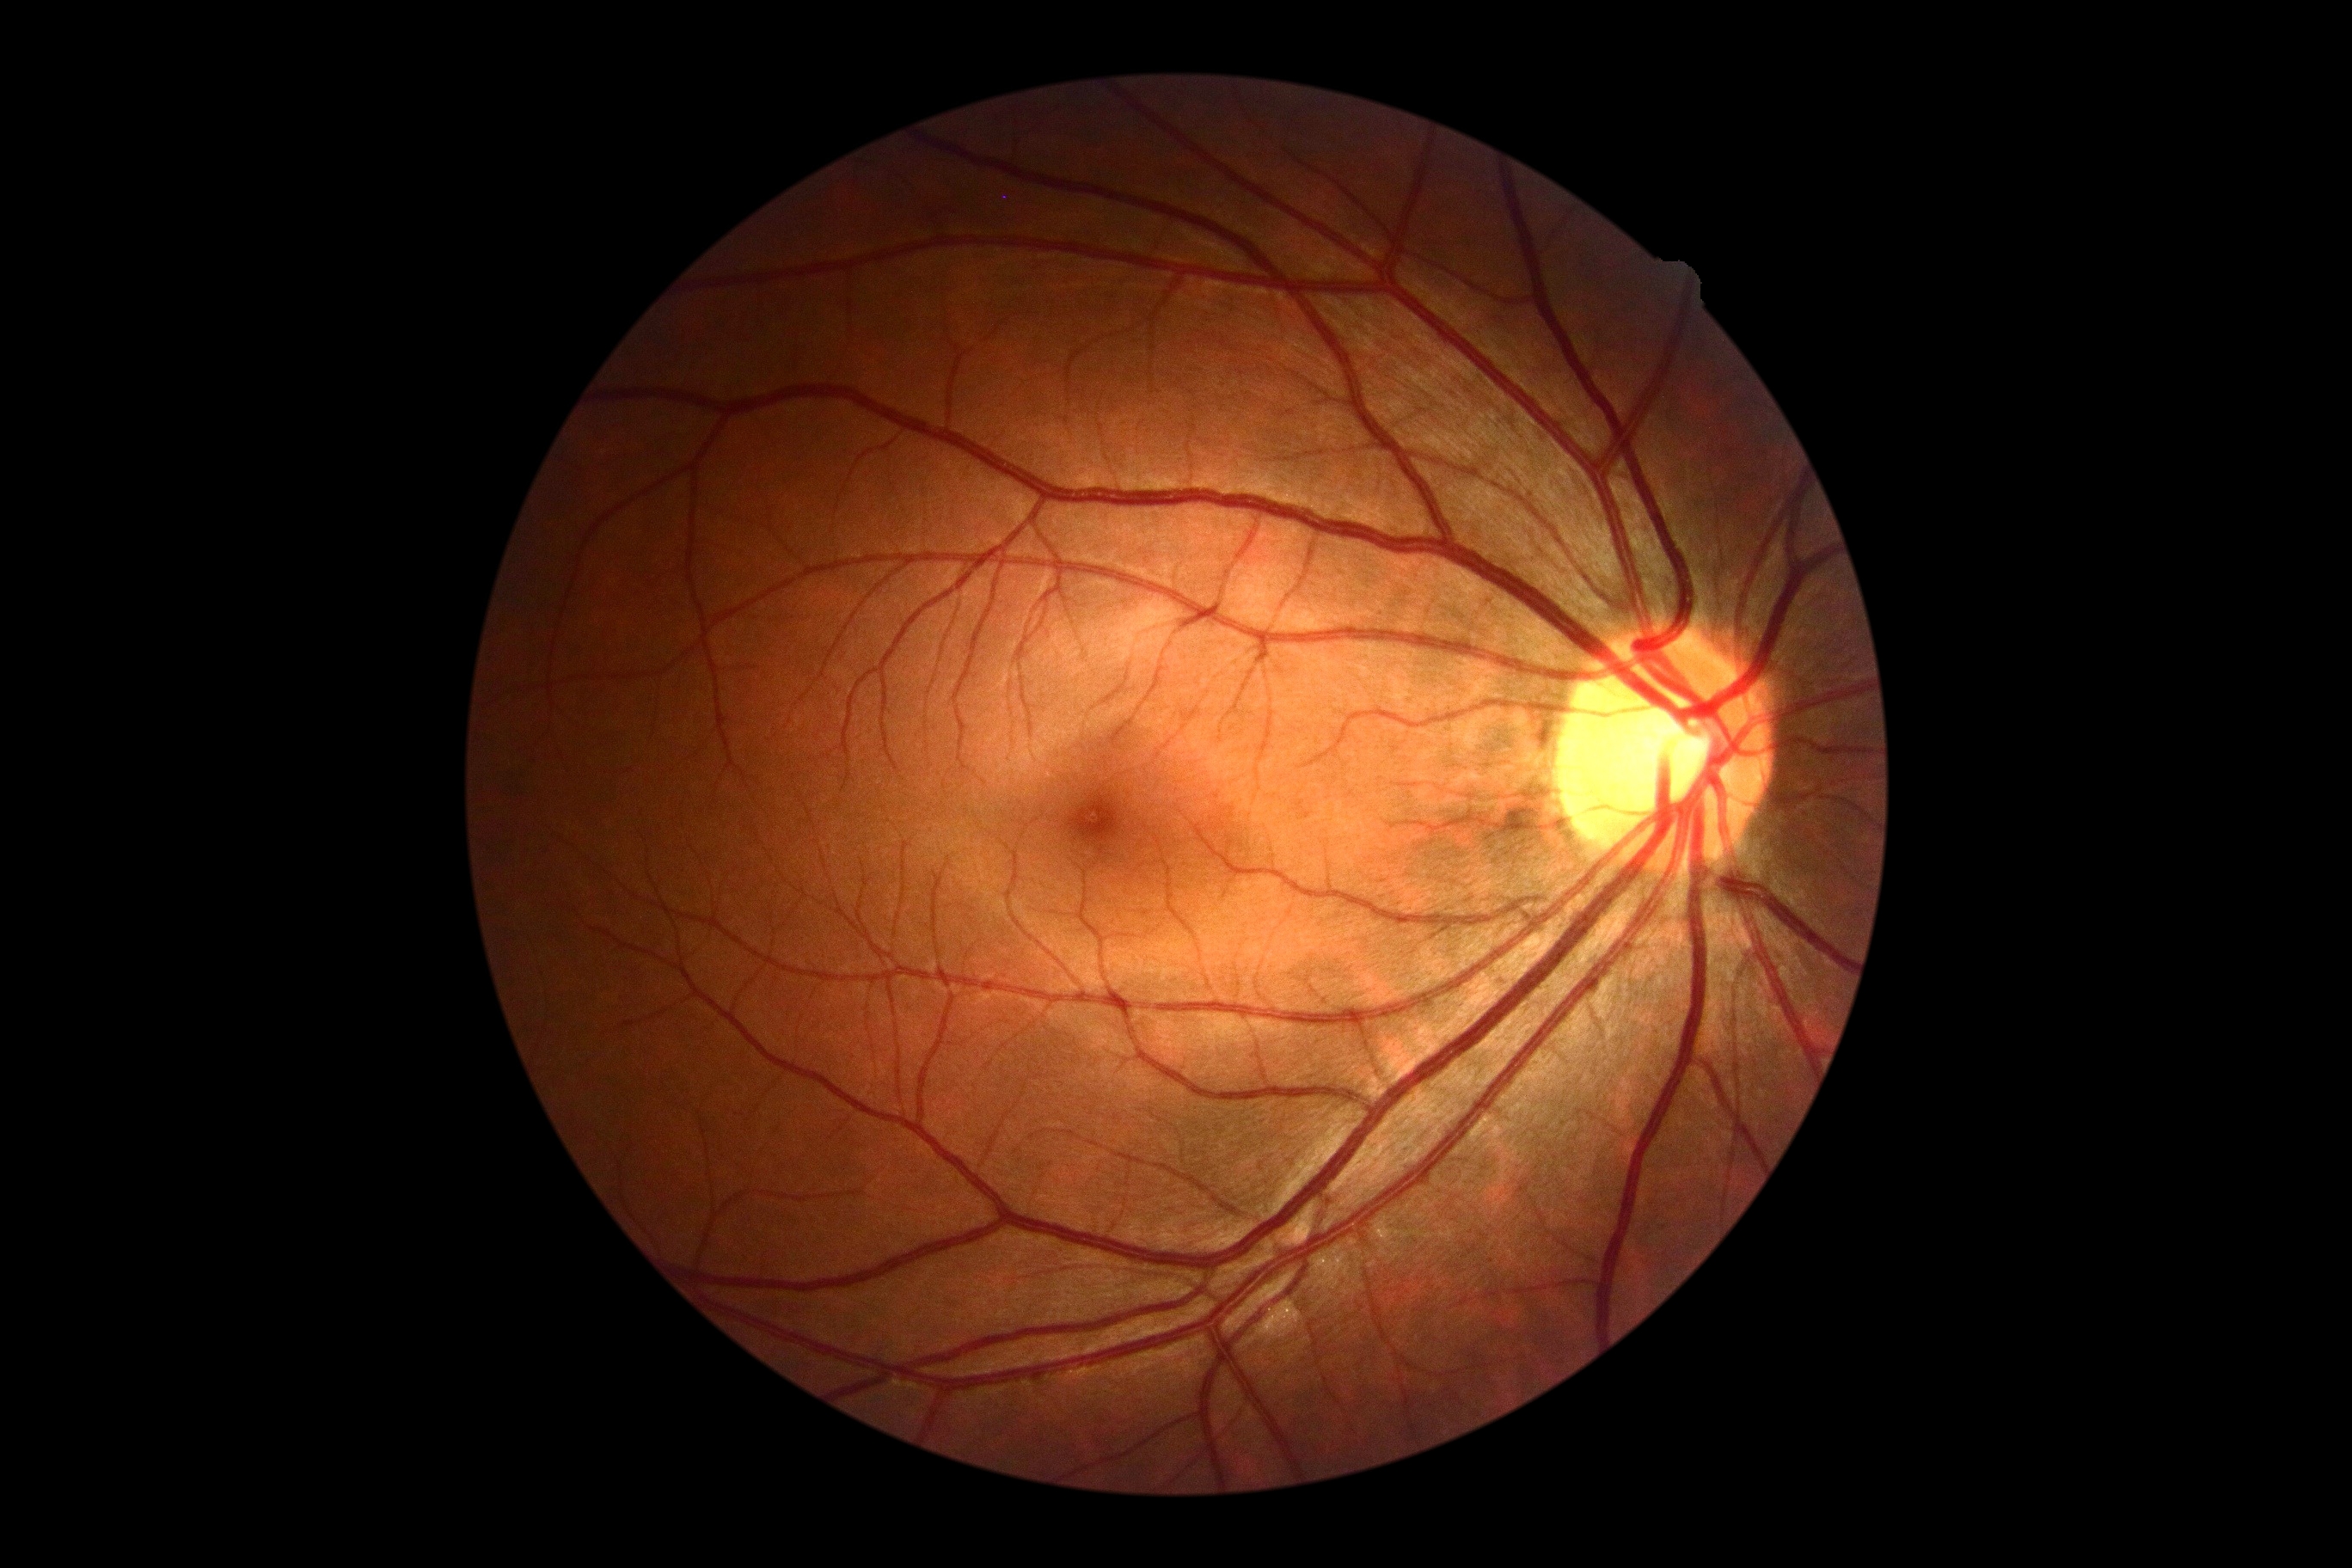

Findings:
– diabetic retinopathy severity — no apparent retinopathy (grade 0)
– DR impression — negative for DR